2352 by 1568 pixels.
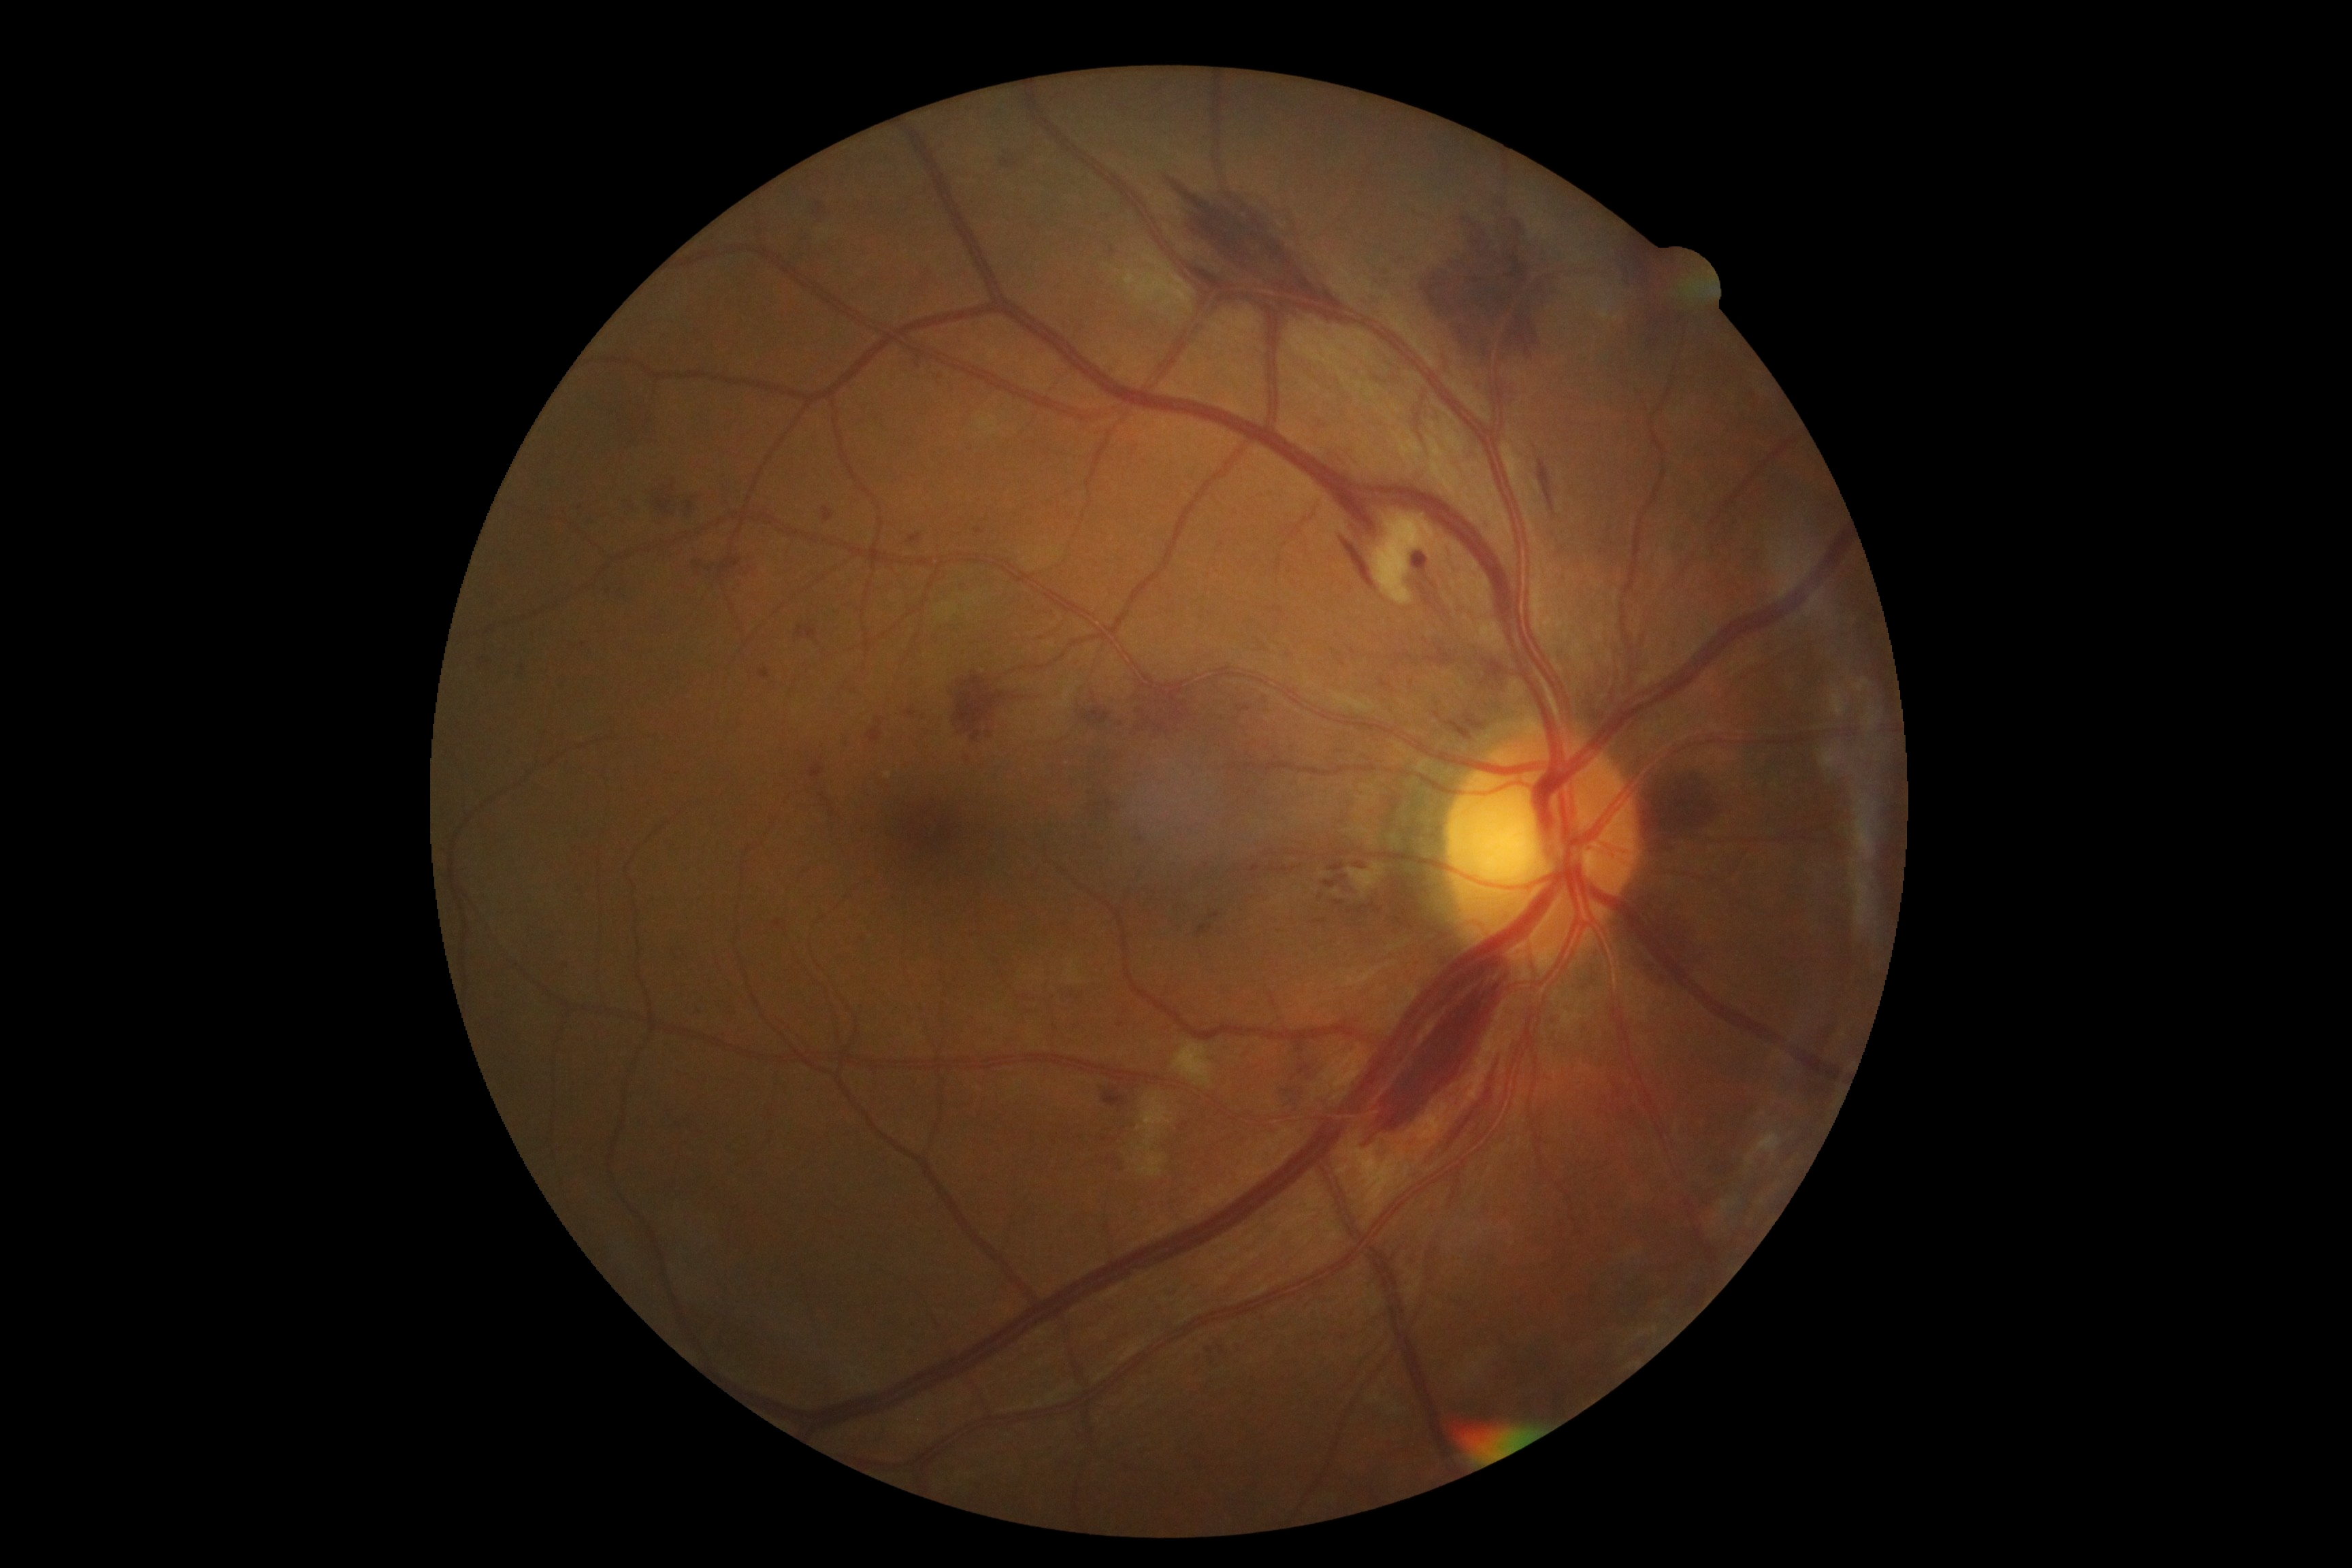
diabetic retinopathy severity: moderate NPDR (grade 2).